Image size 640x480 · 130° field of view (Clarity RetCam 3) · wide-field fundus photograph of an infant
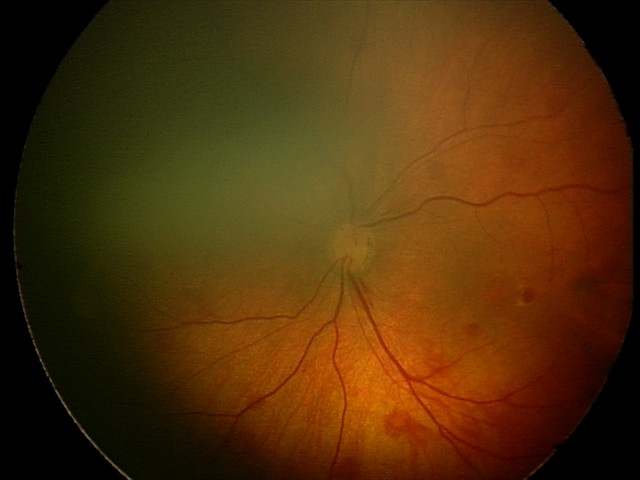
Assessment: retinal hemorrhages.